No pharmacologic dilation · fundus photo — 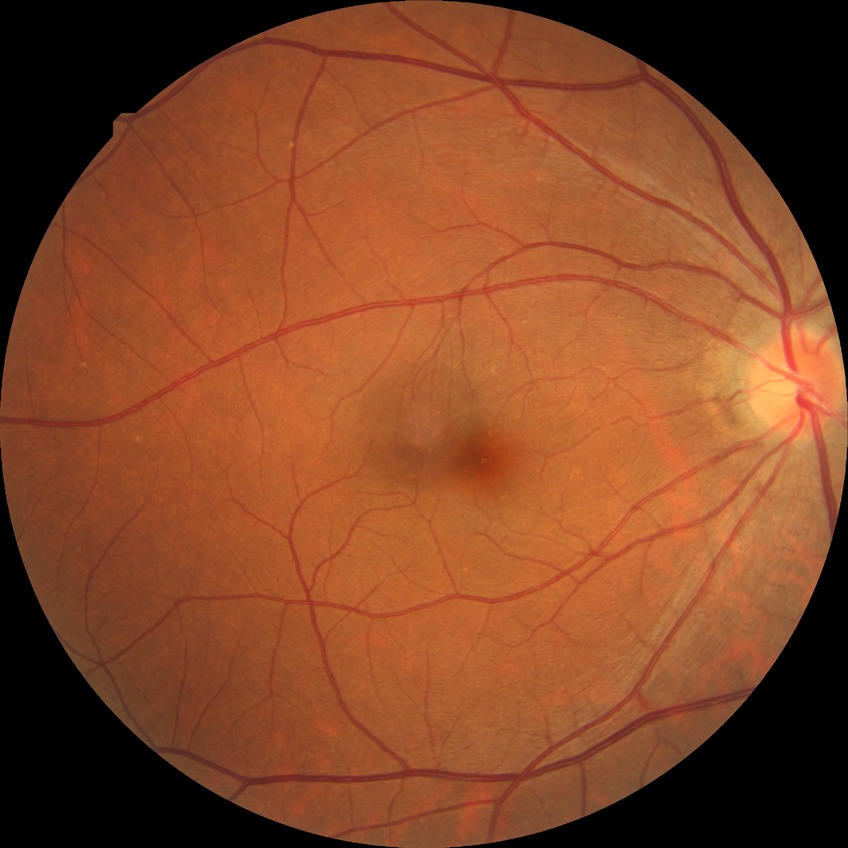 Assessment:
* diabetic retinopathy (DR): no diabetic retinopathy (NDR)